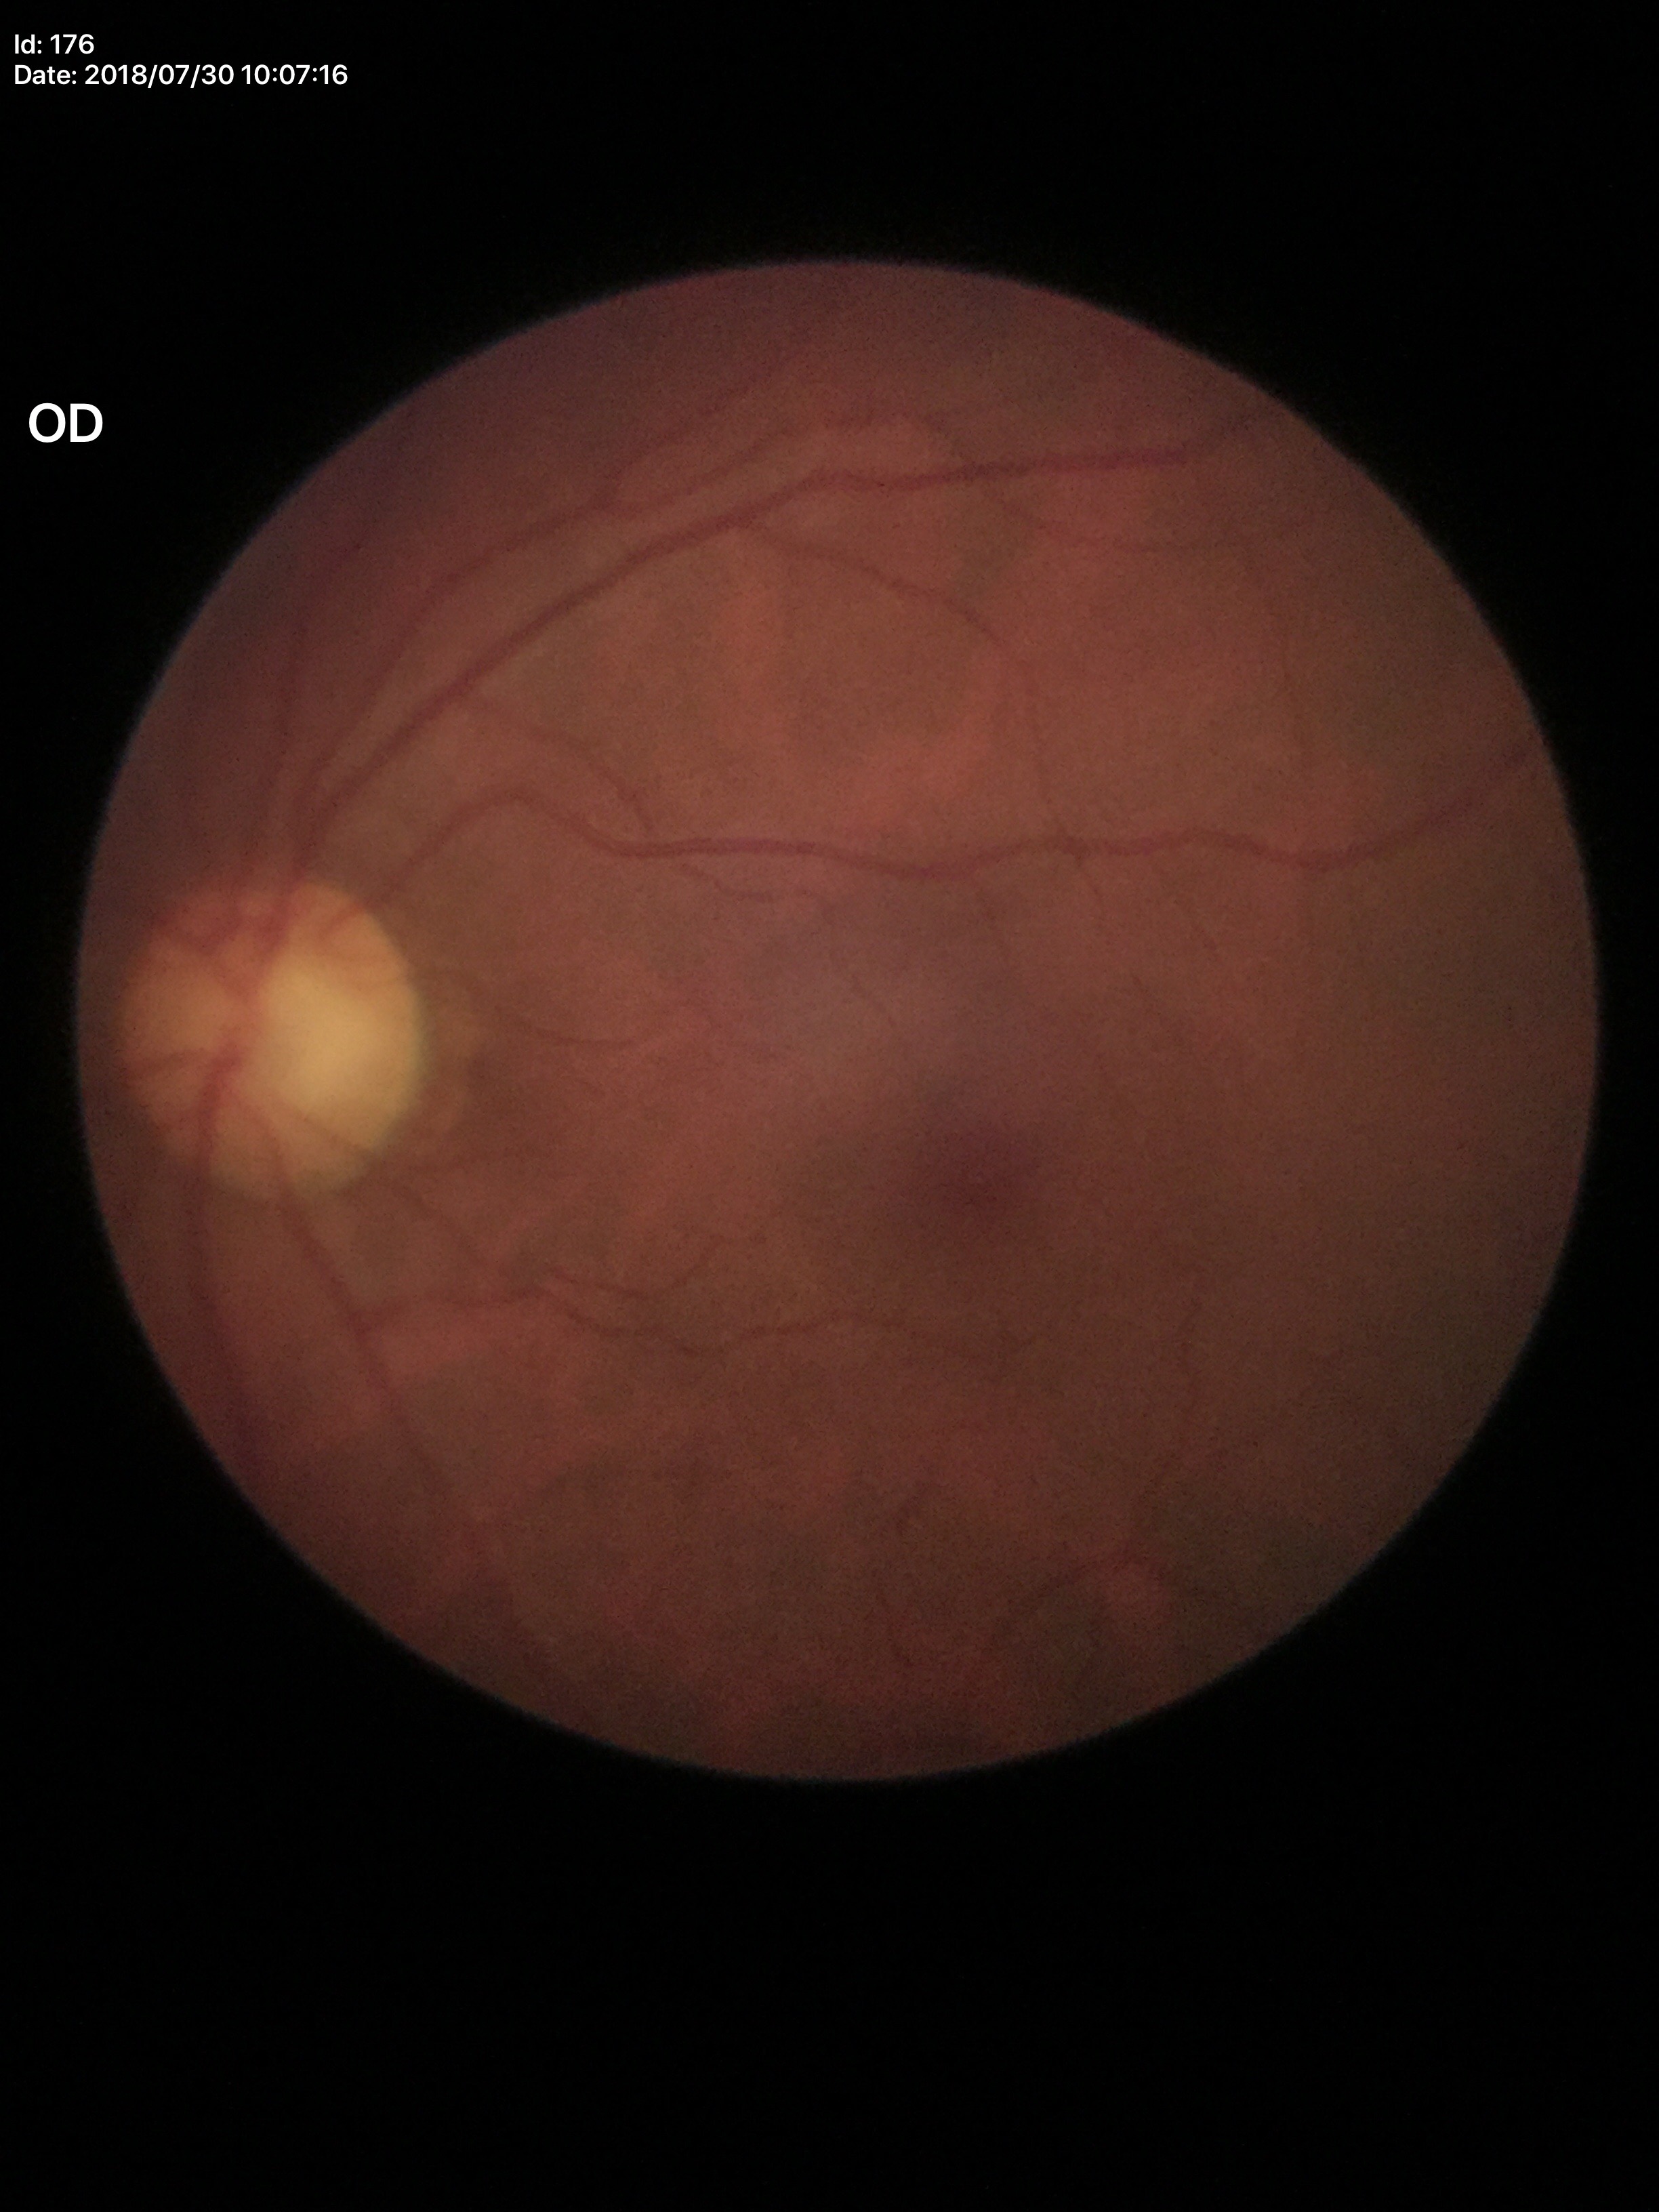

* Glaucoma screening impression · no suspicious findings
* vertical cup-disc ratio · 0.57
* horizontal C/D ratio · 0.59